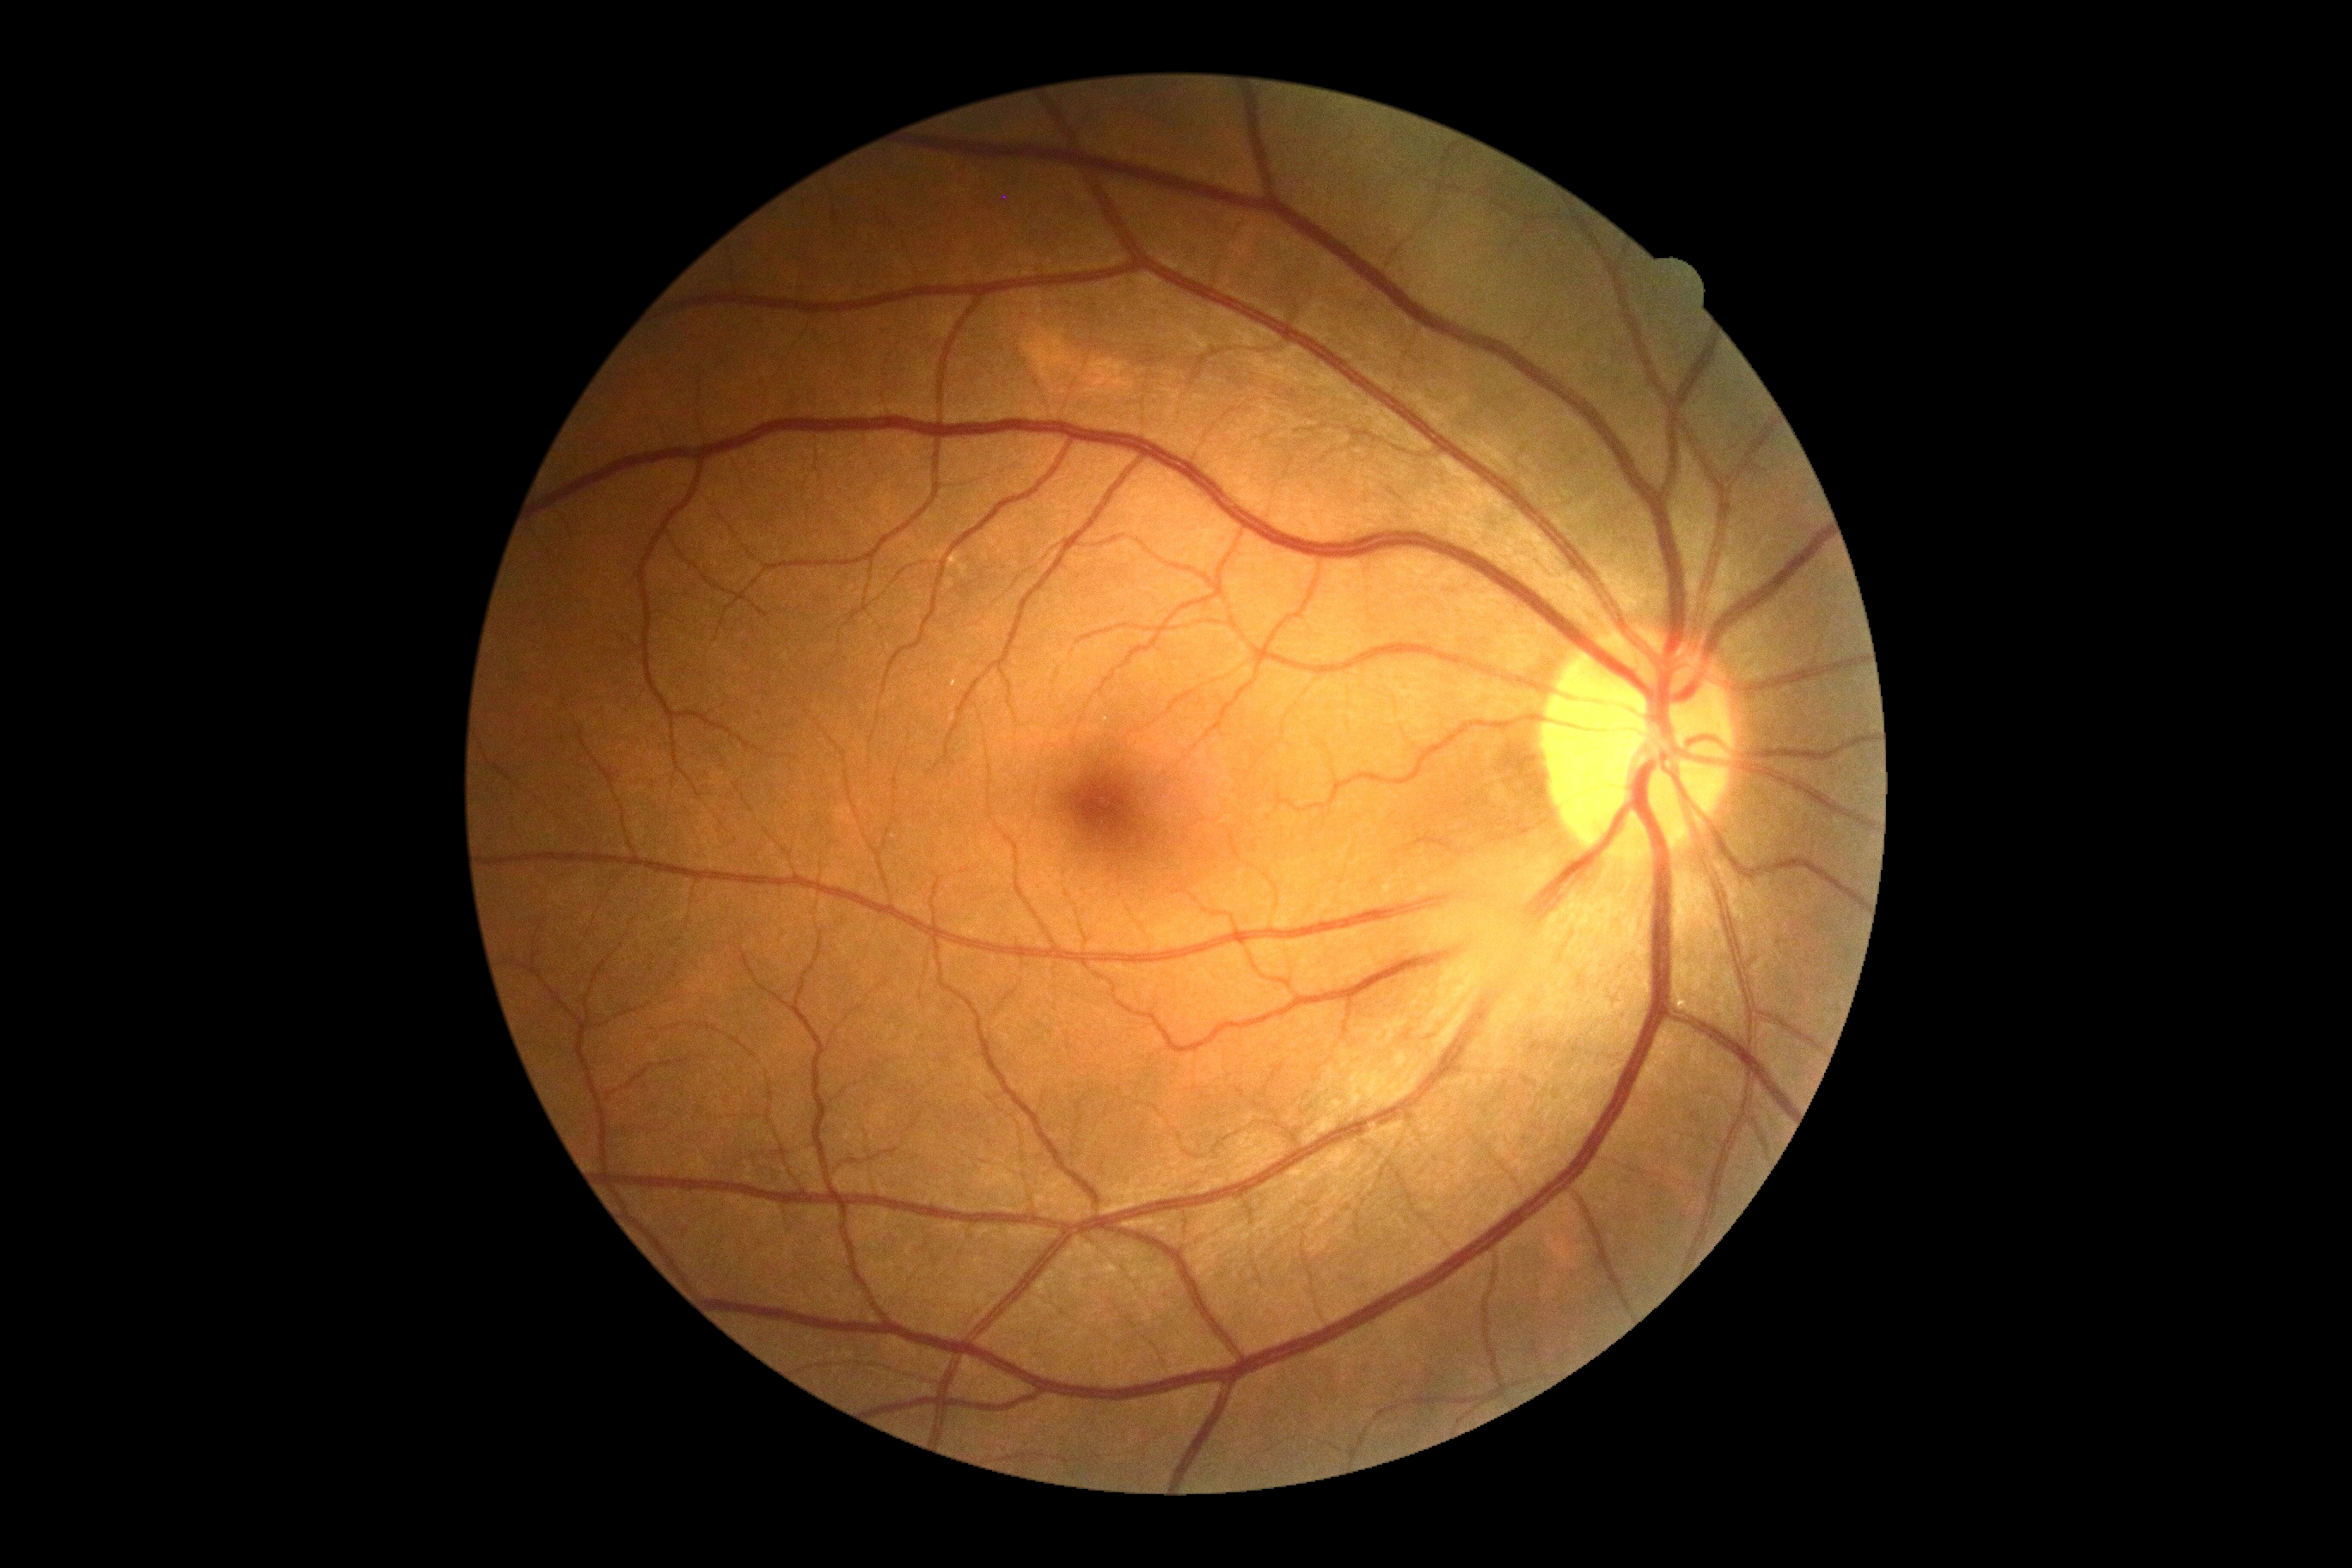
retinopathy grade: no apparent diabetic retinopathy (0).